50-degree field of view, posterior pole field covering the optic disc and macula.
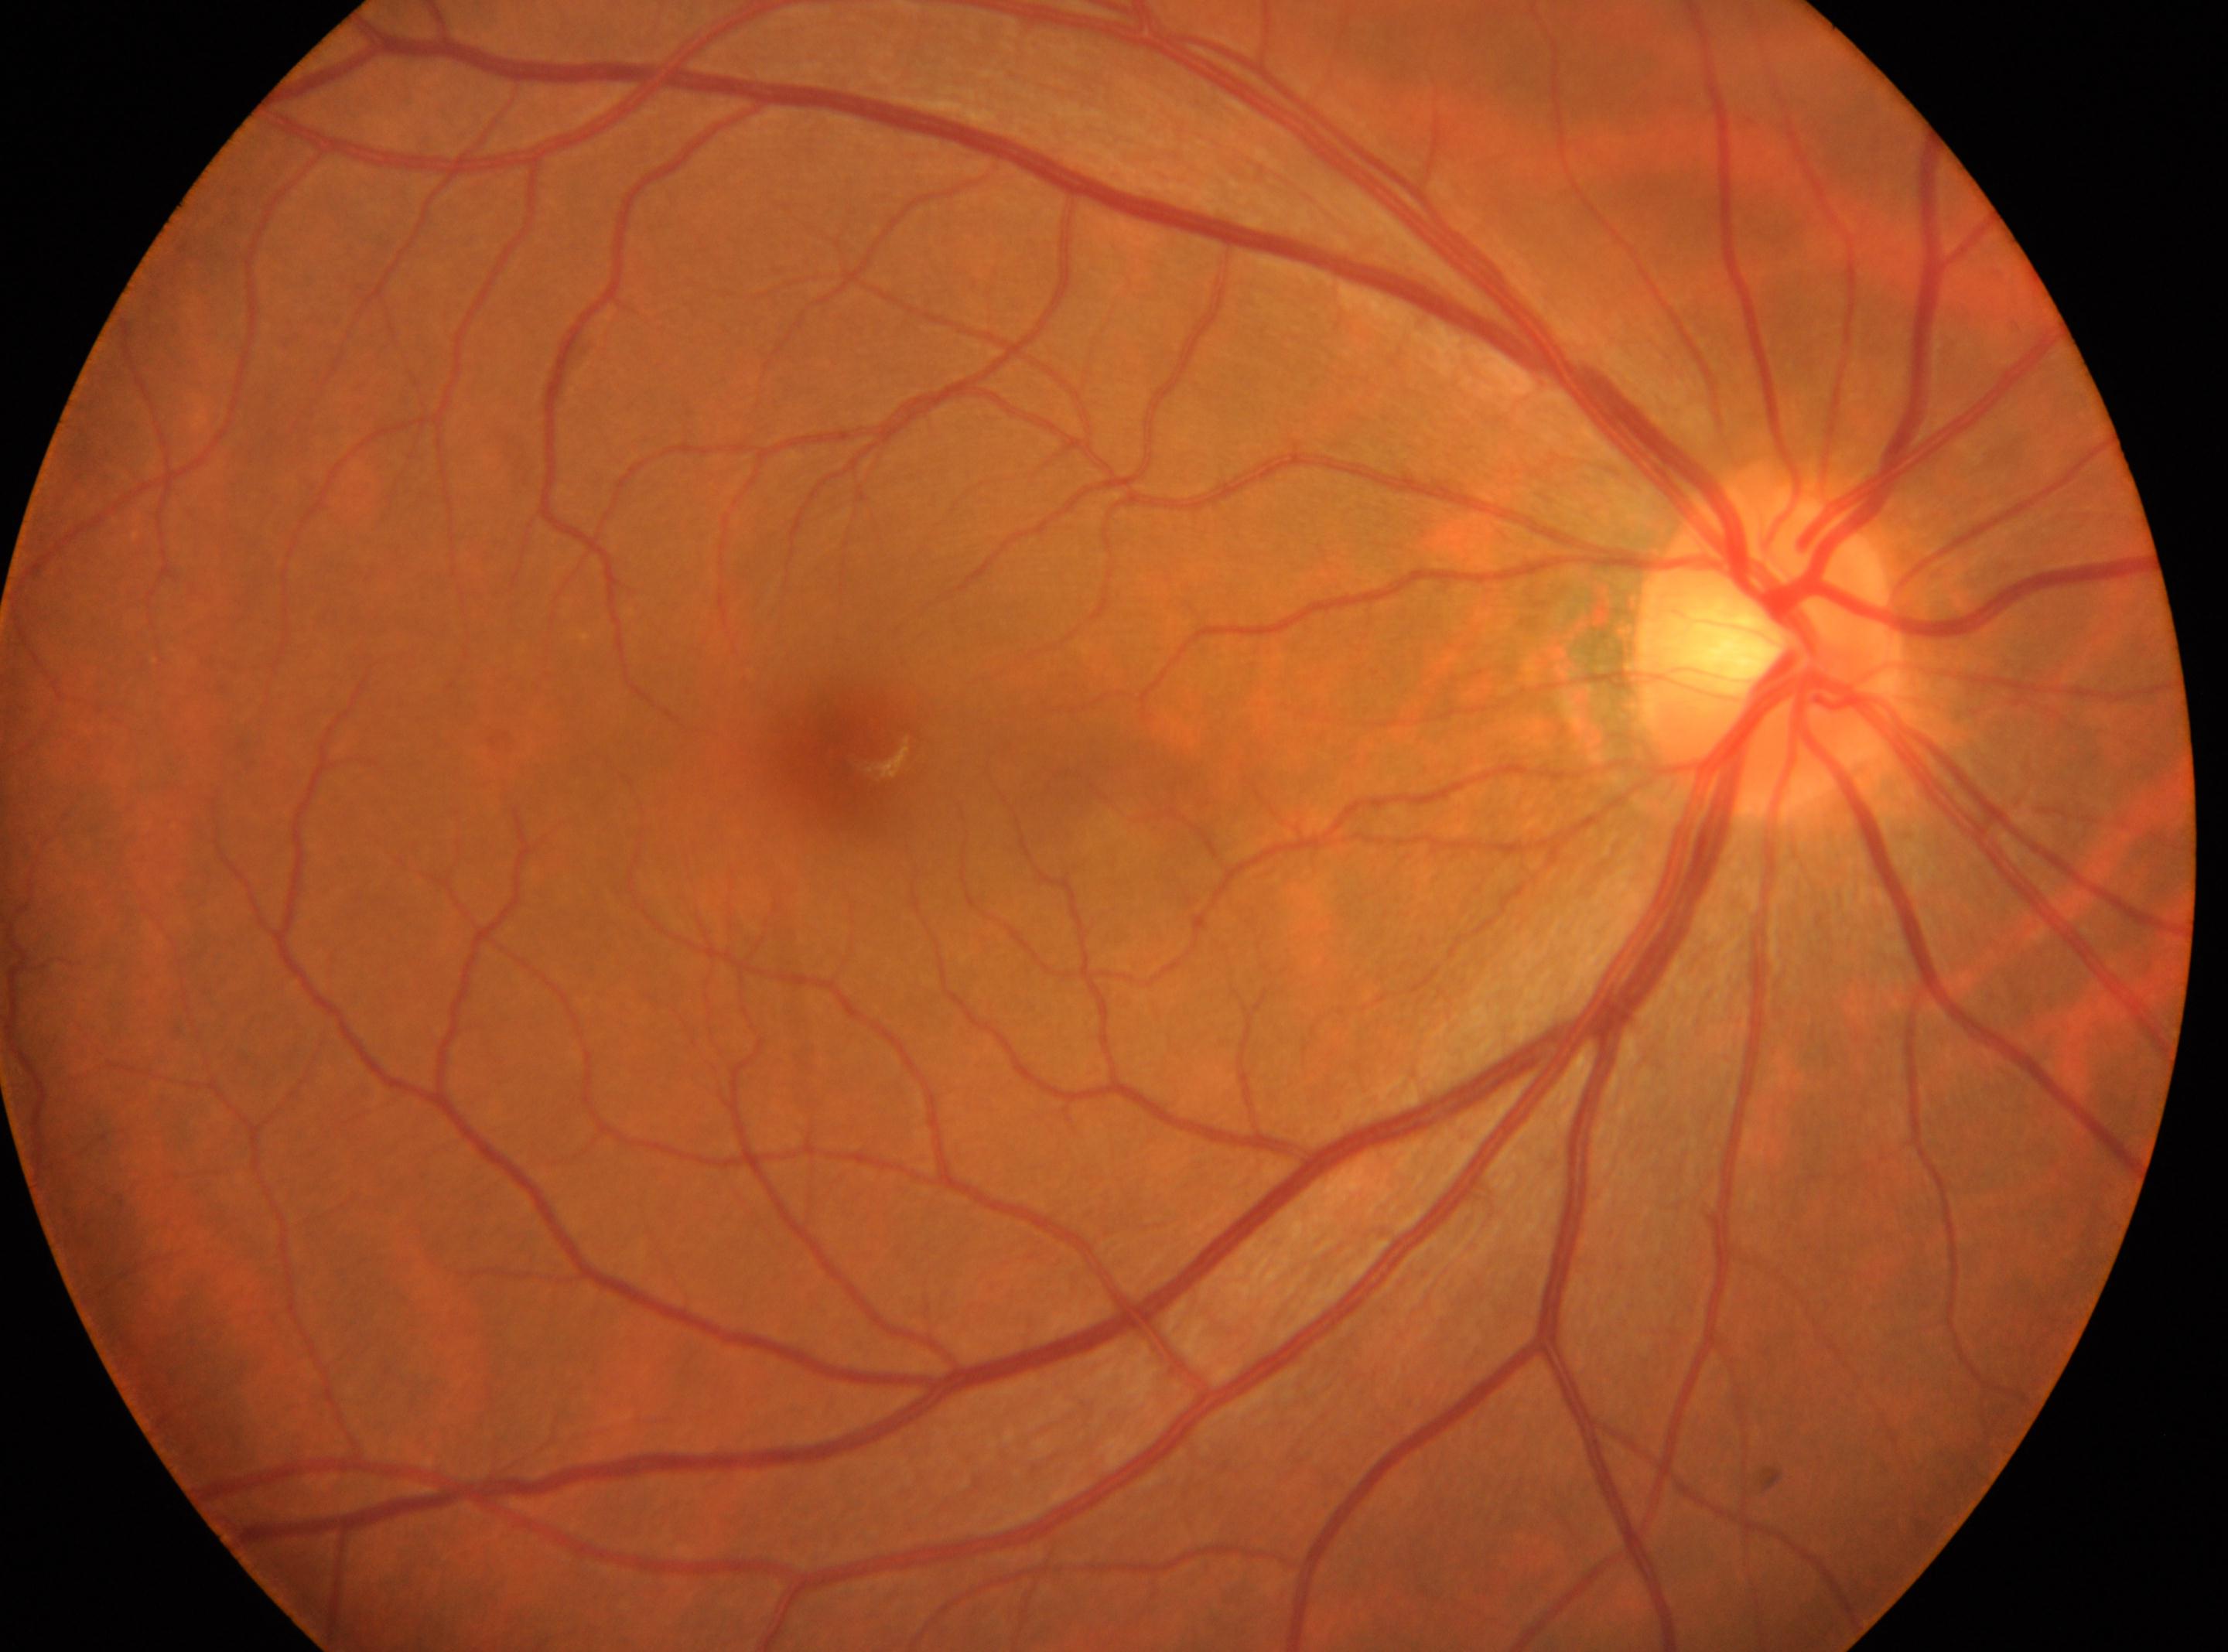

The image shows the right eye. Disc center: 1768, 645. Diabetic retinopathy (DR) is no apparent retinopathy (grade 0). No apparent diabetic retinopathy. The macular center is at 849, 750.